Image size 2089x1764: 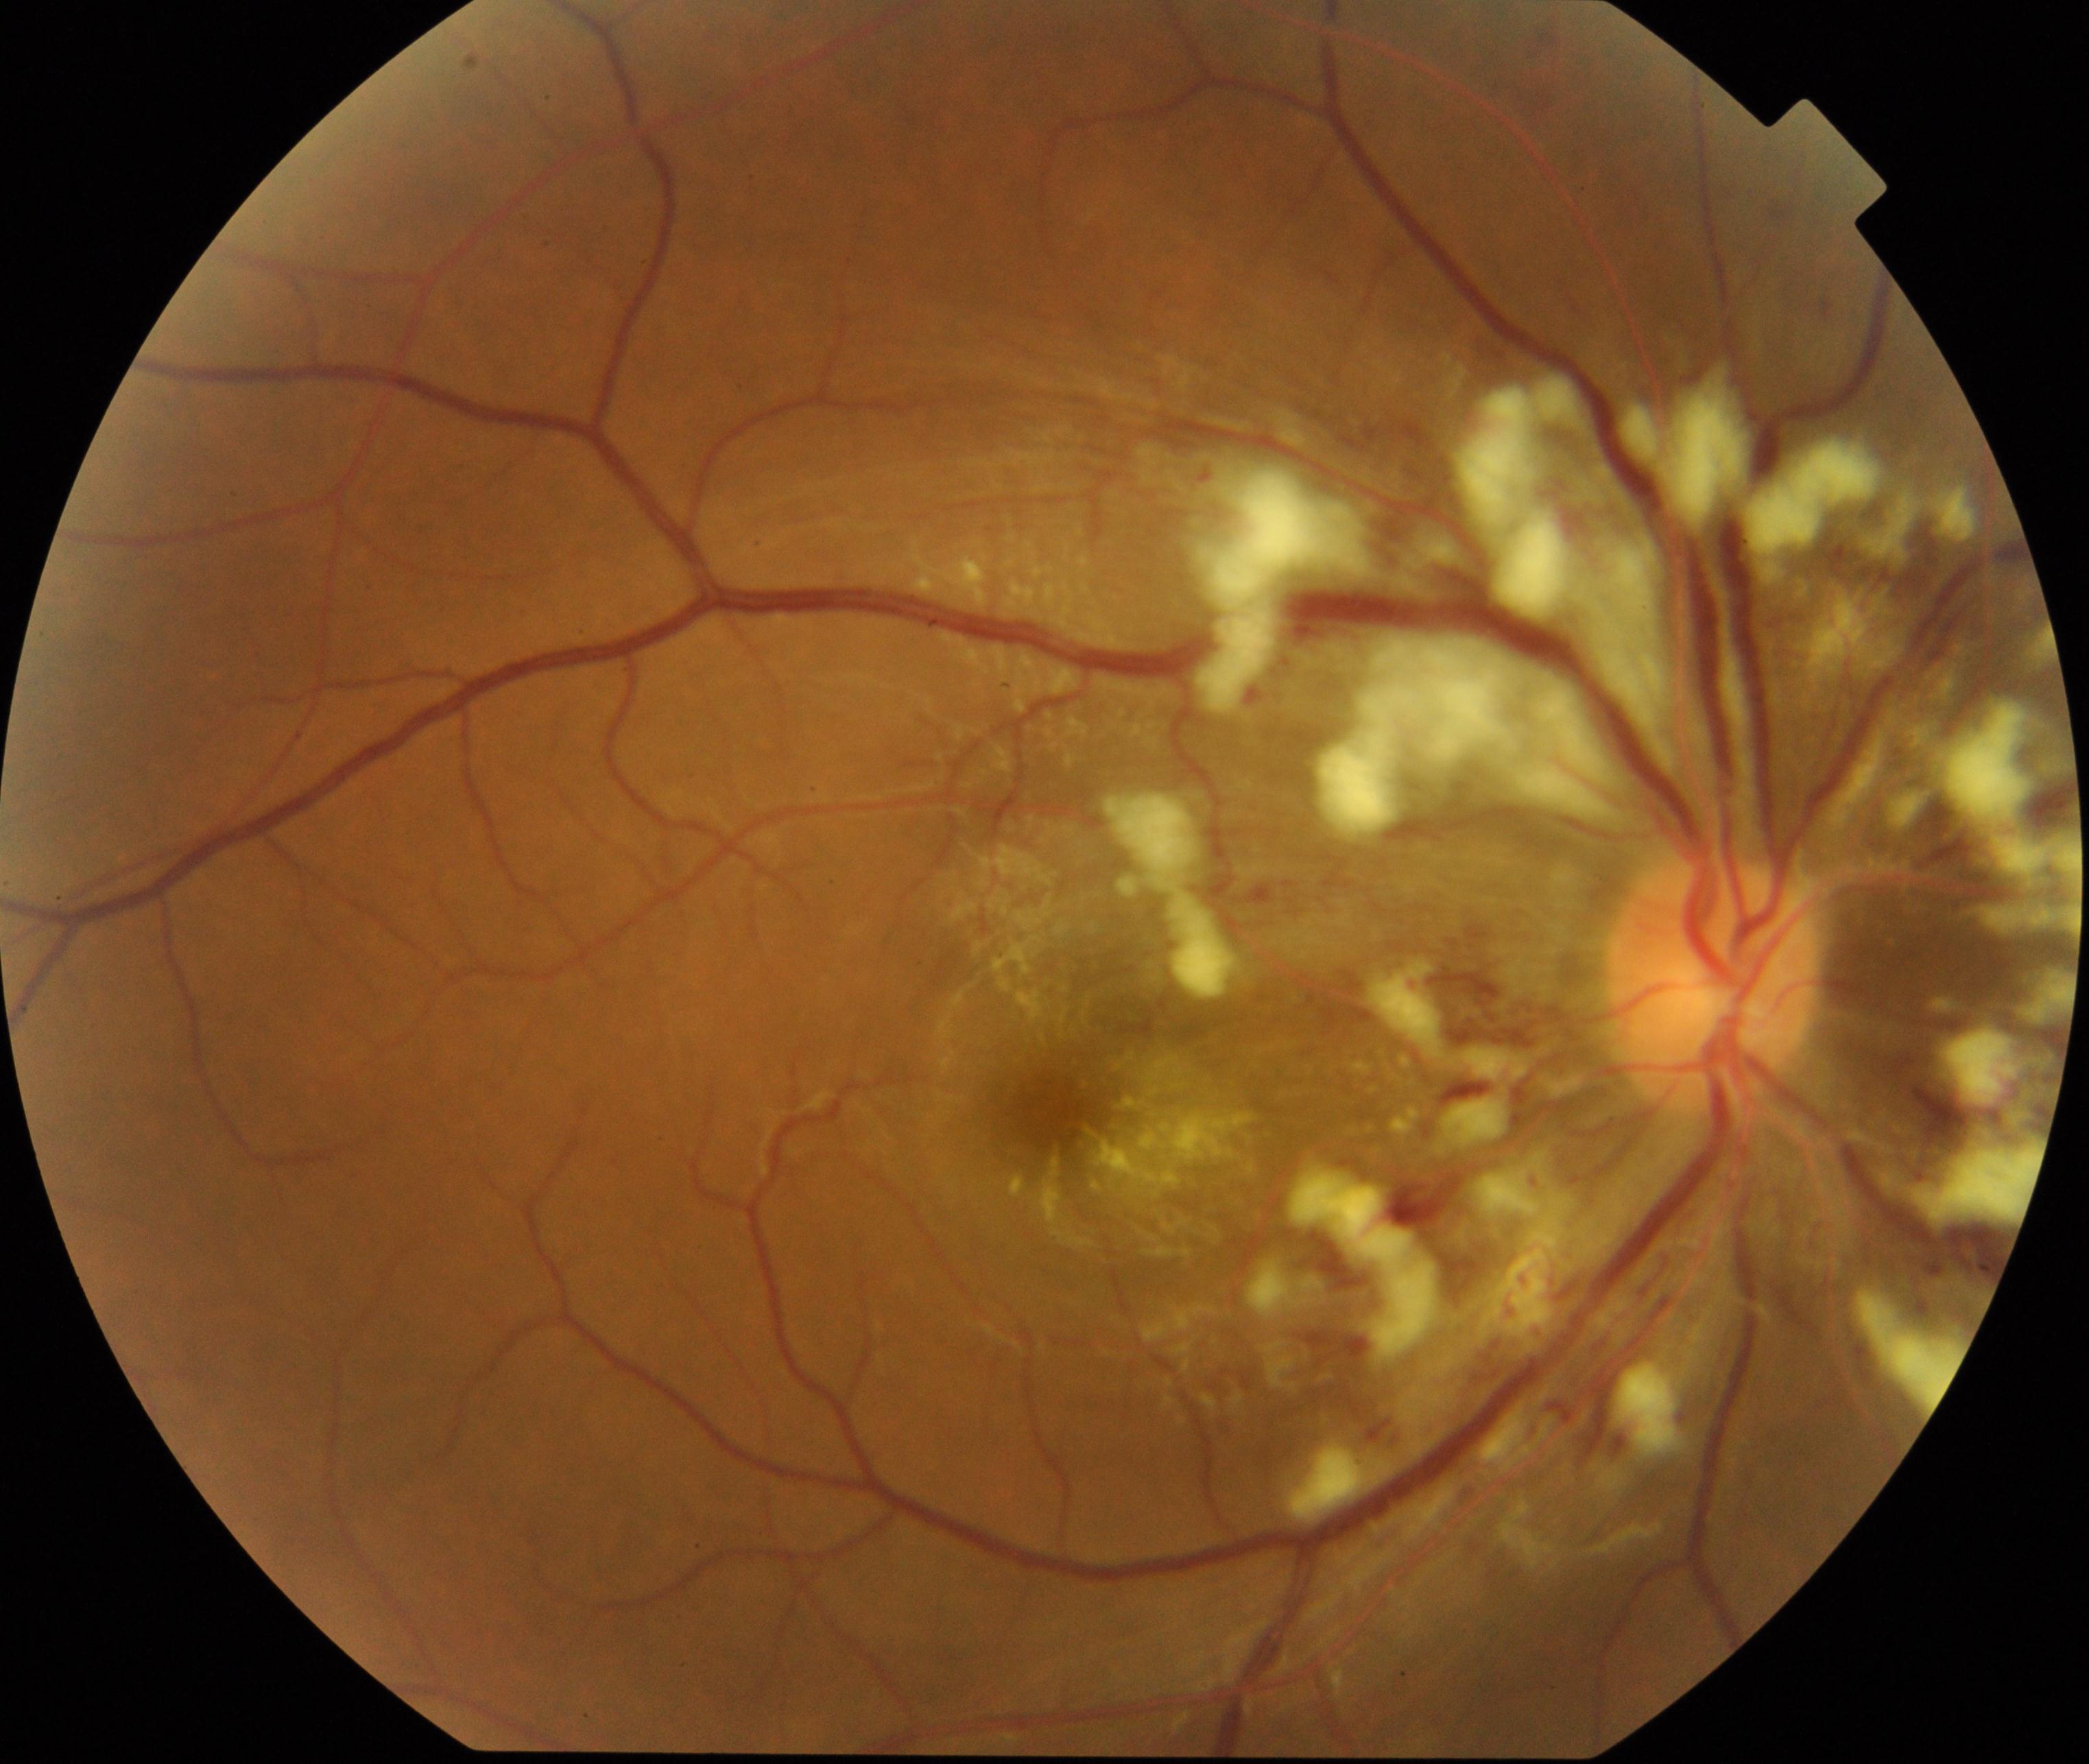 This fundus photograph shows severe hypertensive retinopathy. Characterized by cotton-wool spots, arteriolar narrowing, arteriolosclerosis, flame-shaped hemorrhages, retinal edema, macular star, and disc edema.